45-degree field of view — 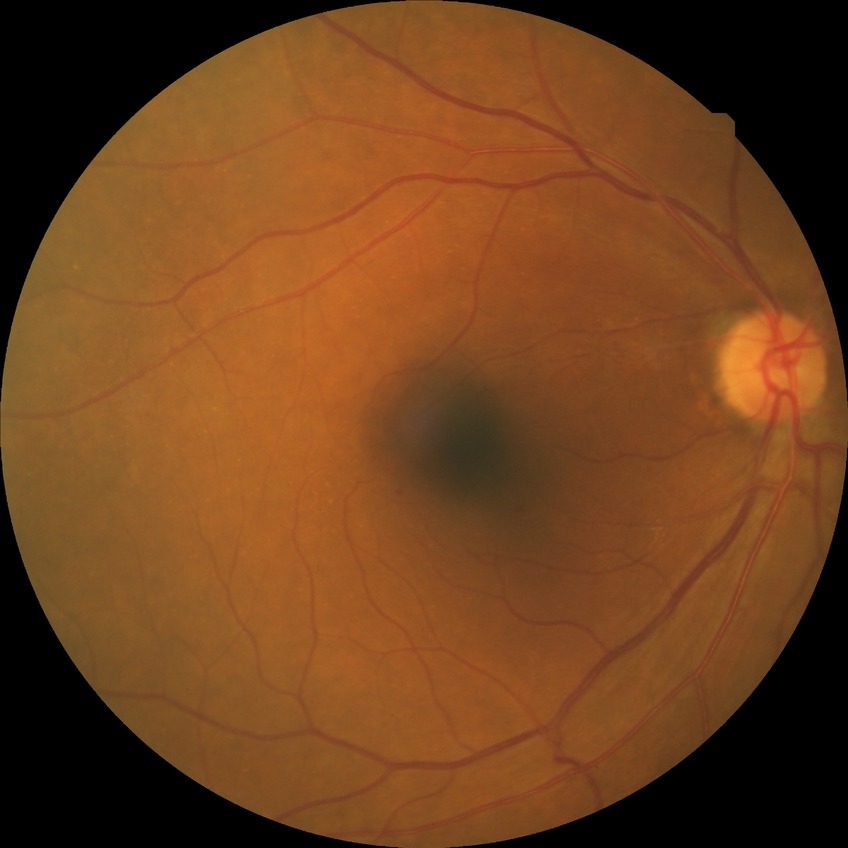
Disease class: non-proliferative diabetic retinopathy. Davis grading: simple diabetic retinopathy.